Wide-field fundus photograph of an infant; captured with the Clarity RetCam 3 (130° field of view):
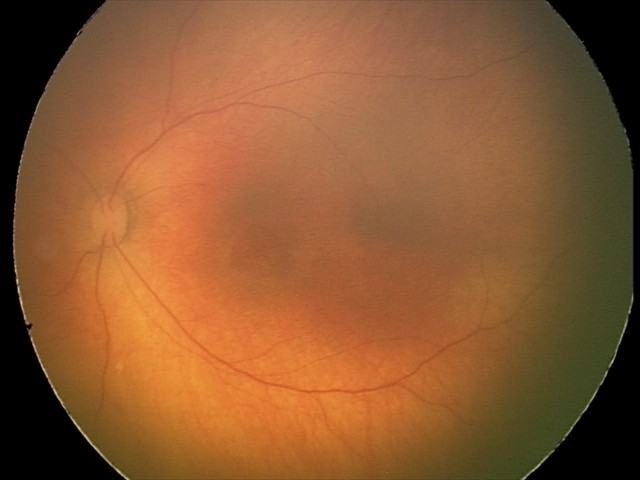

Screening examination with no abnormal retinal findings.